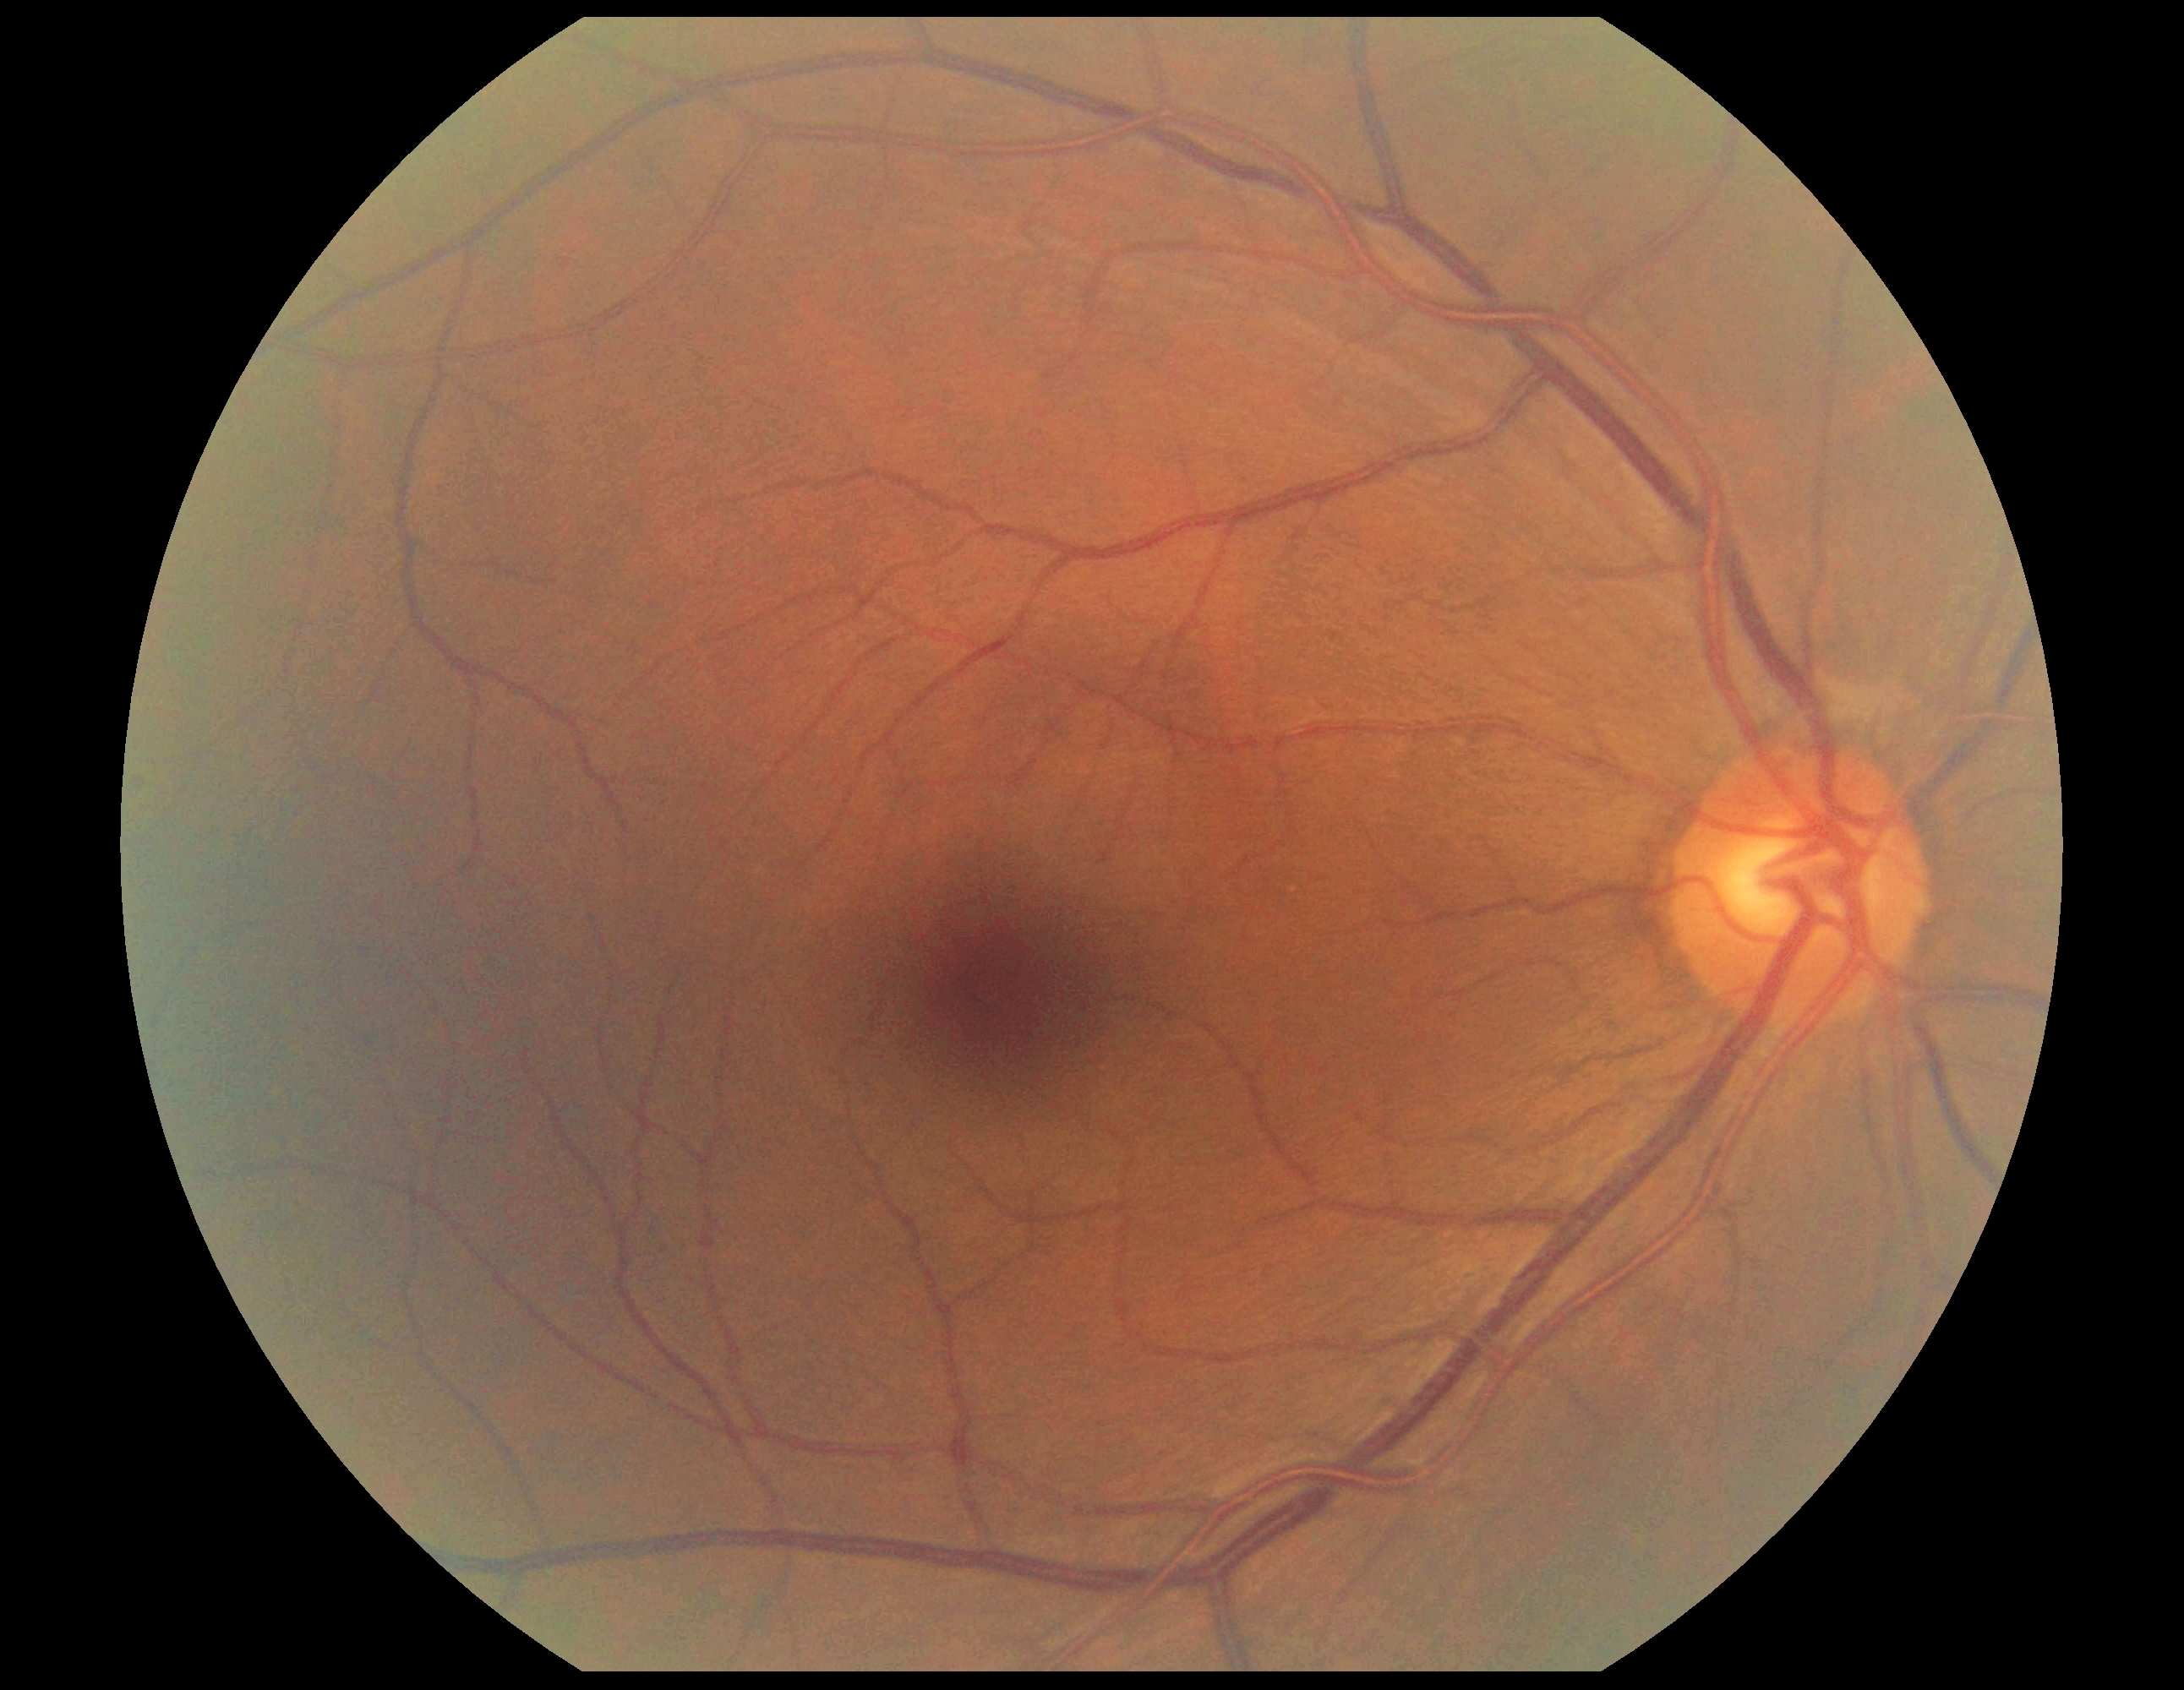

DR impression = no DR findings
DR stage = grade 0 (no apparent retinopathy)